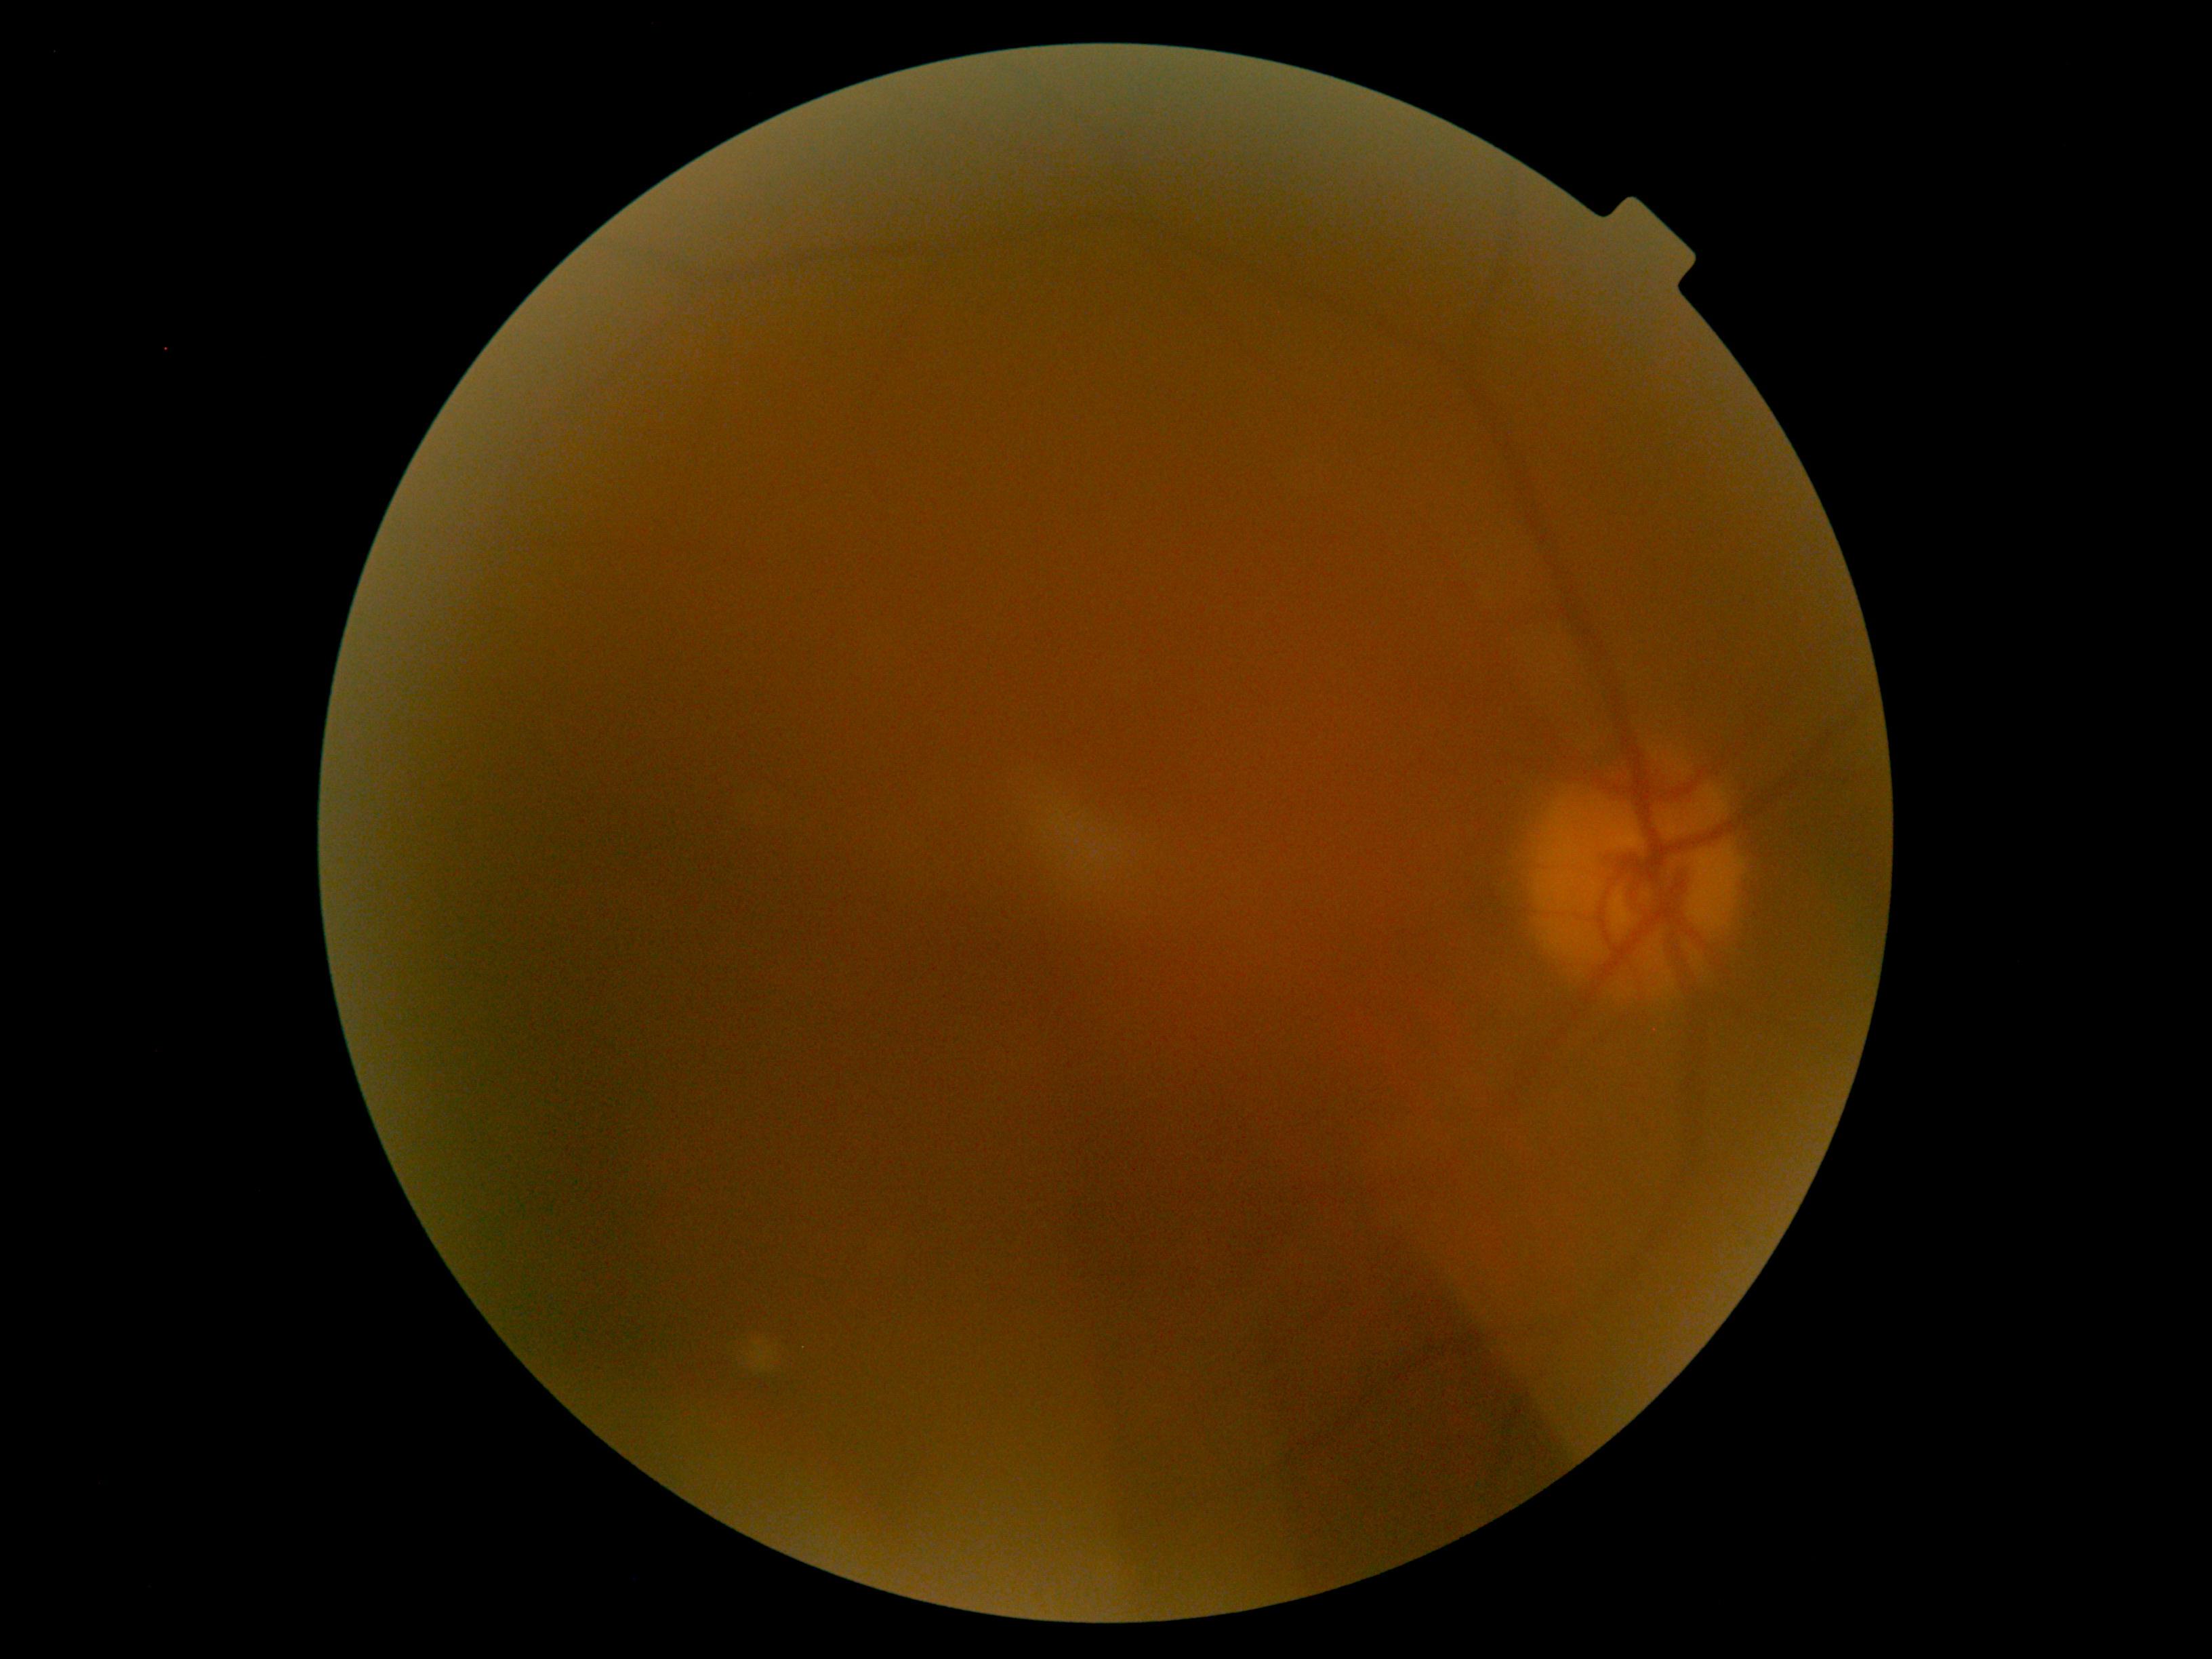

Quality too poor to assess for DR.
DR stage: ungradable due to poor image quality.